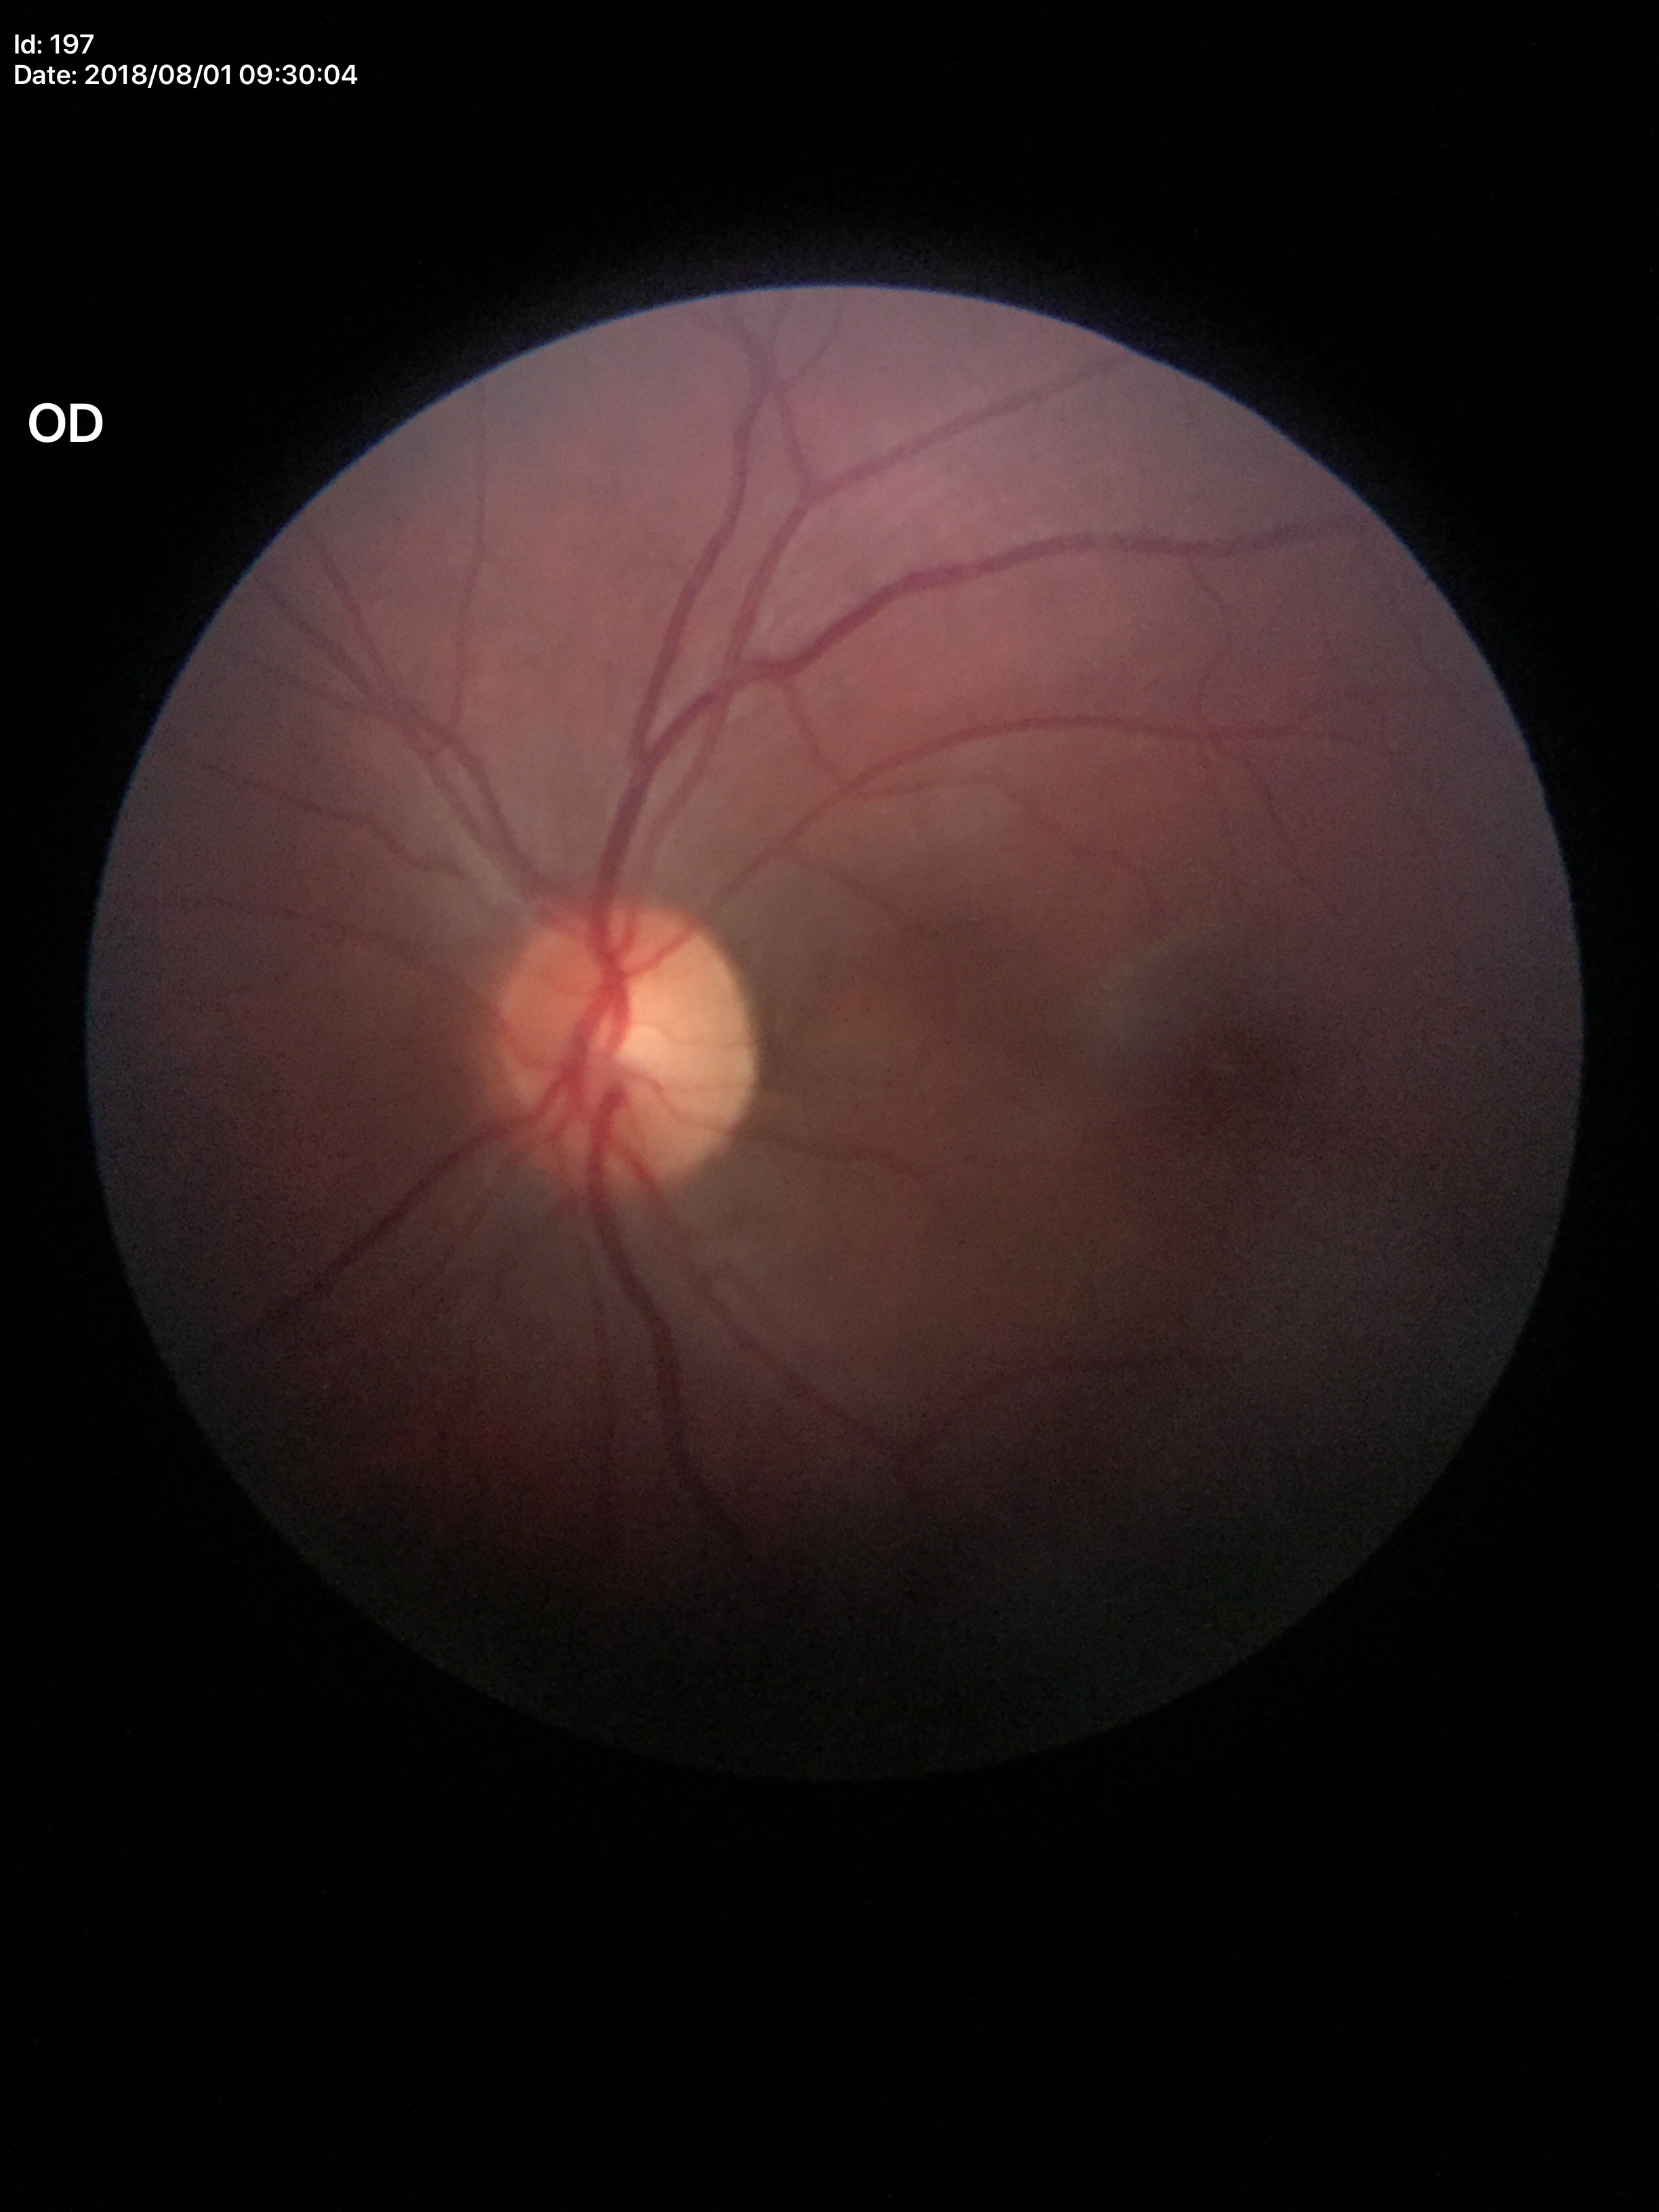
Glaucoma screening: no suspicious findings.
Horizontal C/D ratio: 0.48.
Vertical CDR: 0.52.